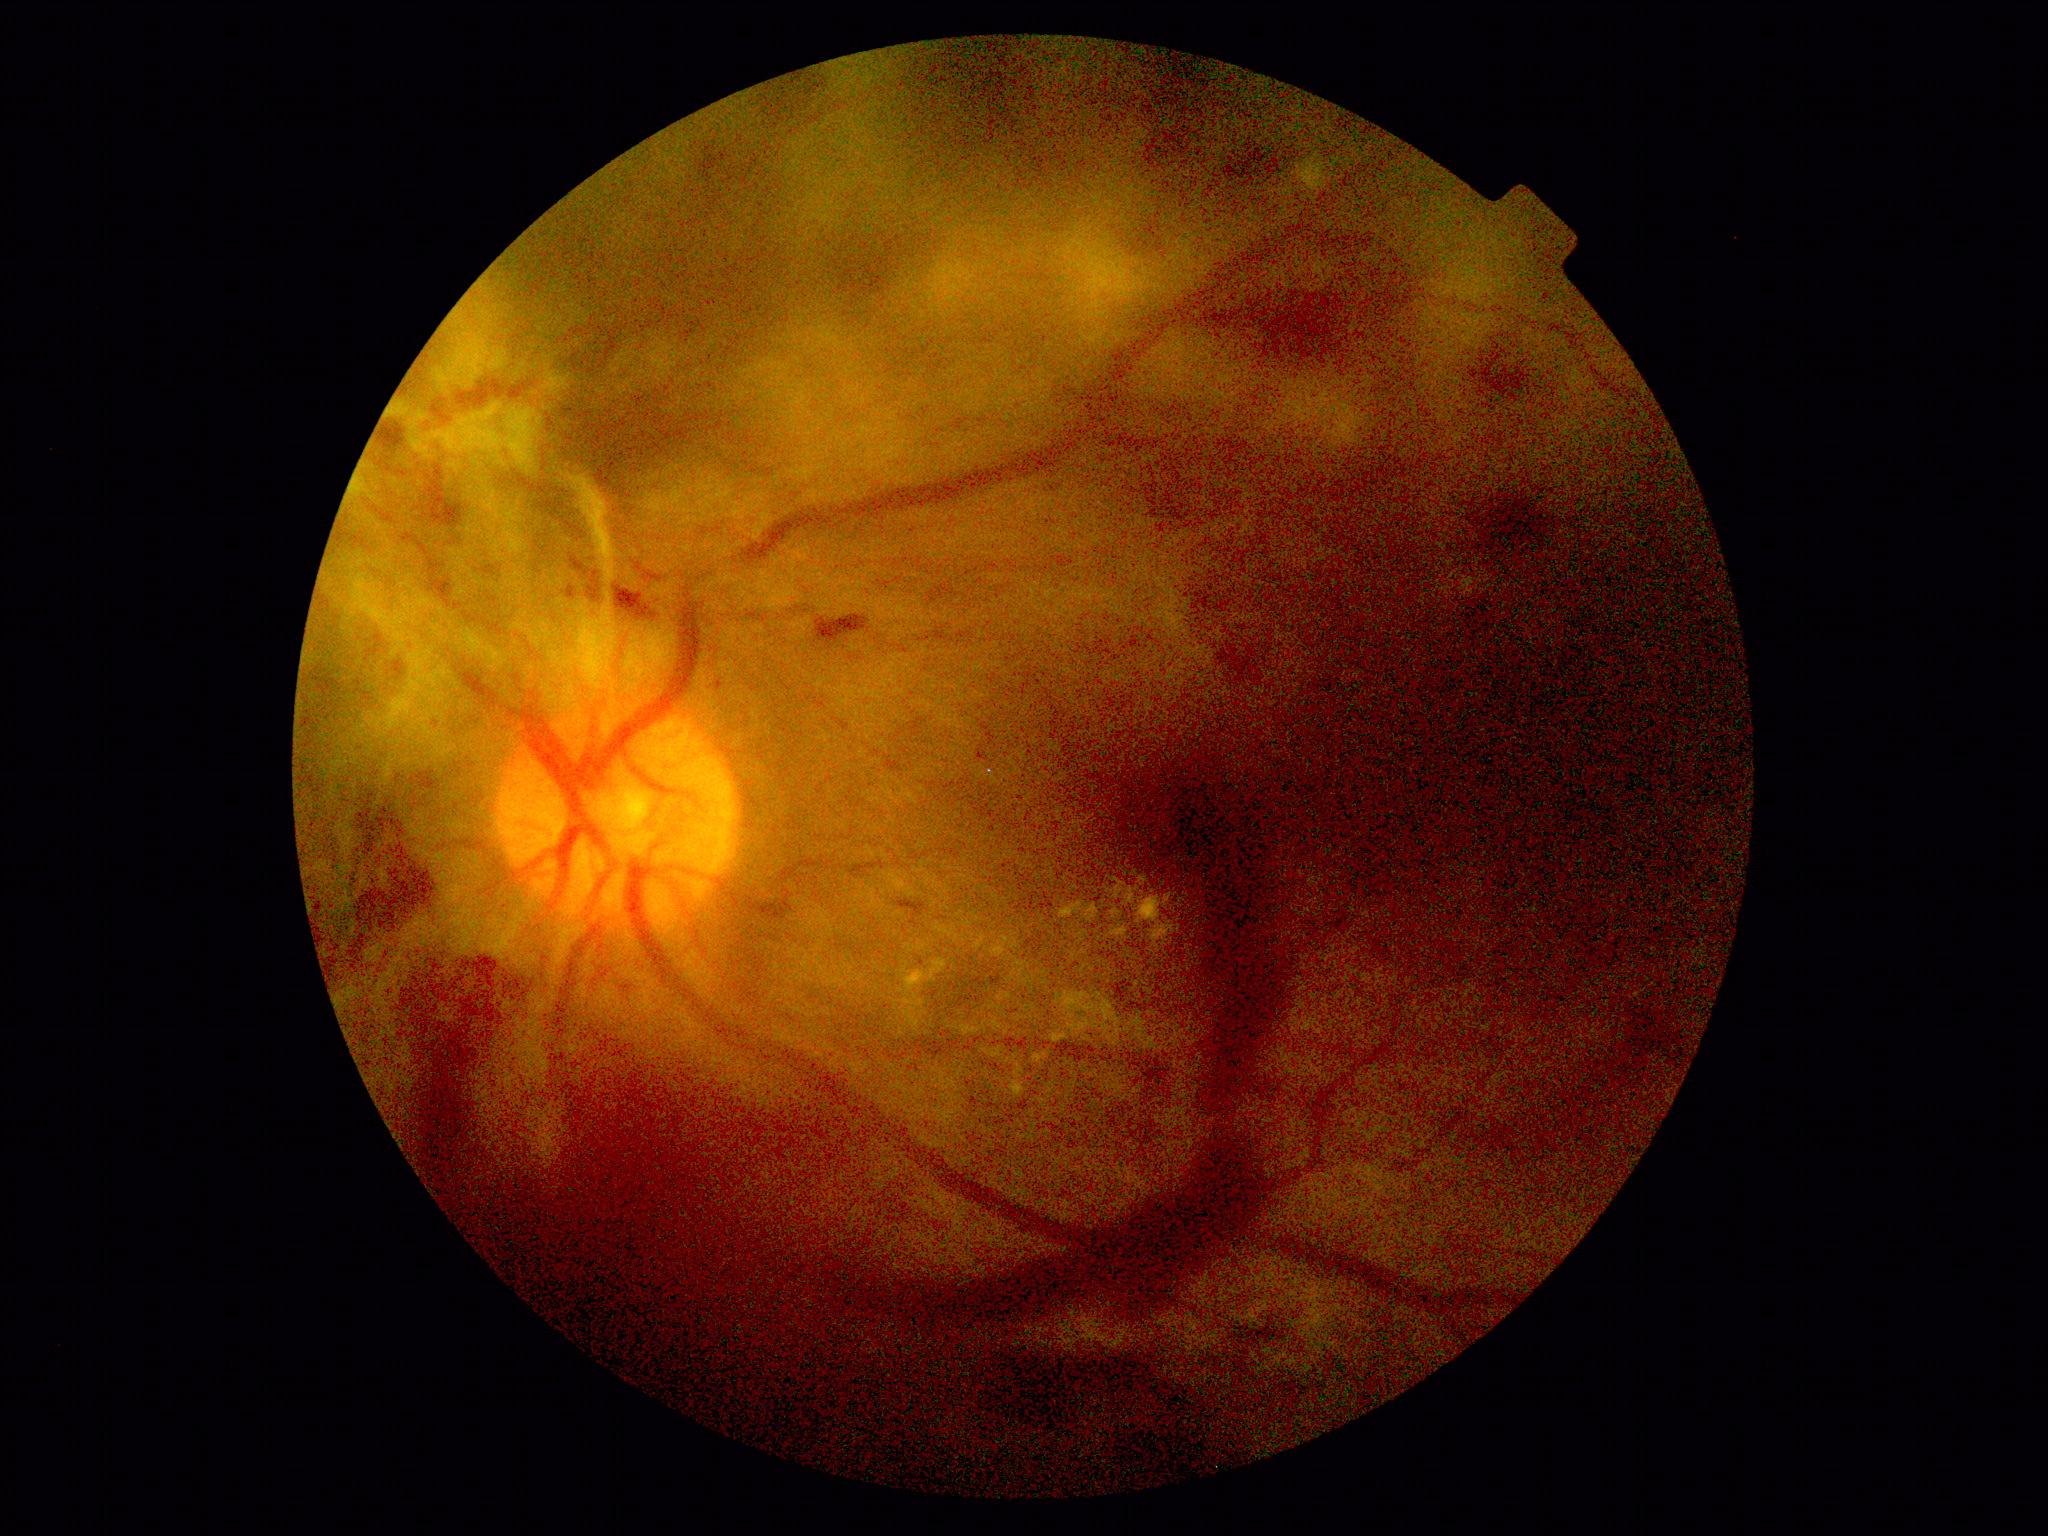
Retinopathy grade is 4 (PDR). DR class: proliferative diabetic retinopathy.